Camera: NIDEK AFC-230 · 45° field of view · retinal fundus photograph · image size 848x848 · no pharmacologic dilation:
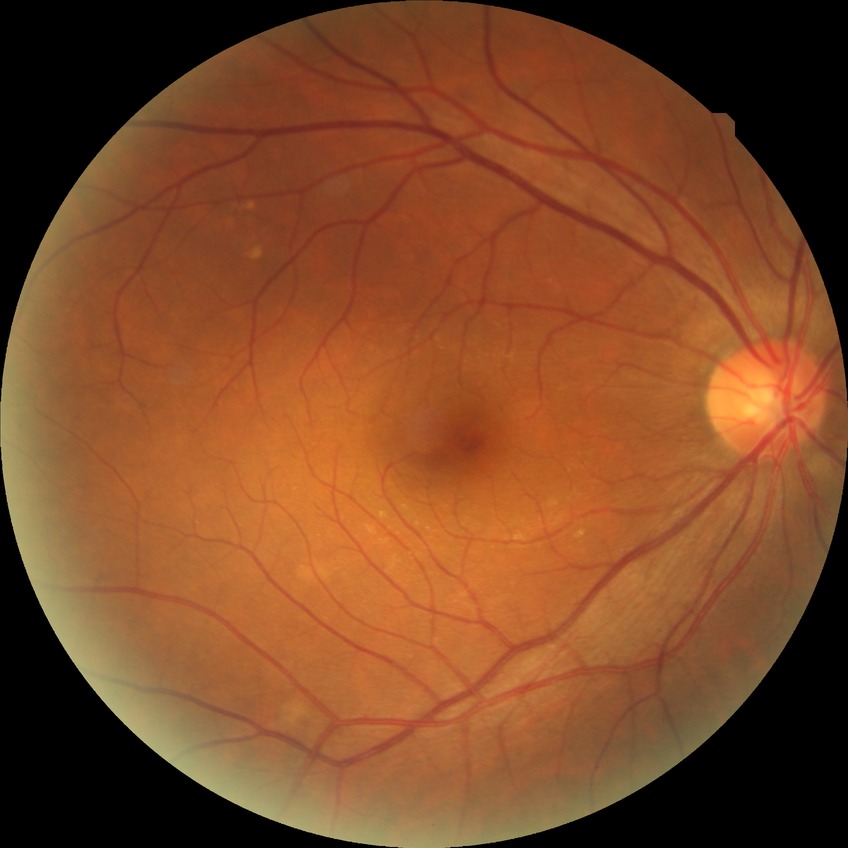 diabetic retinopathy (DR)=no diabetic retinopathy (NDR).